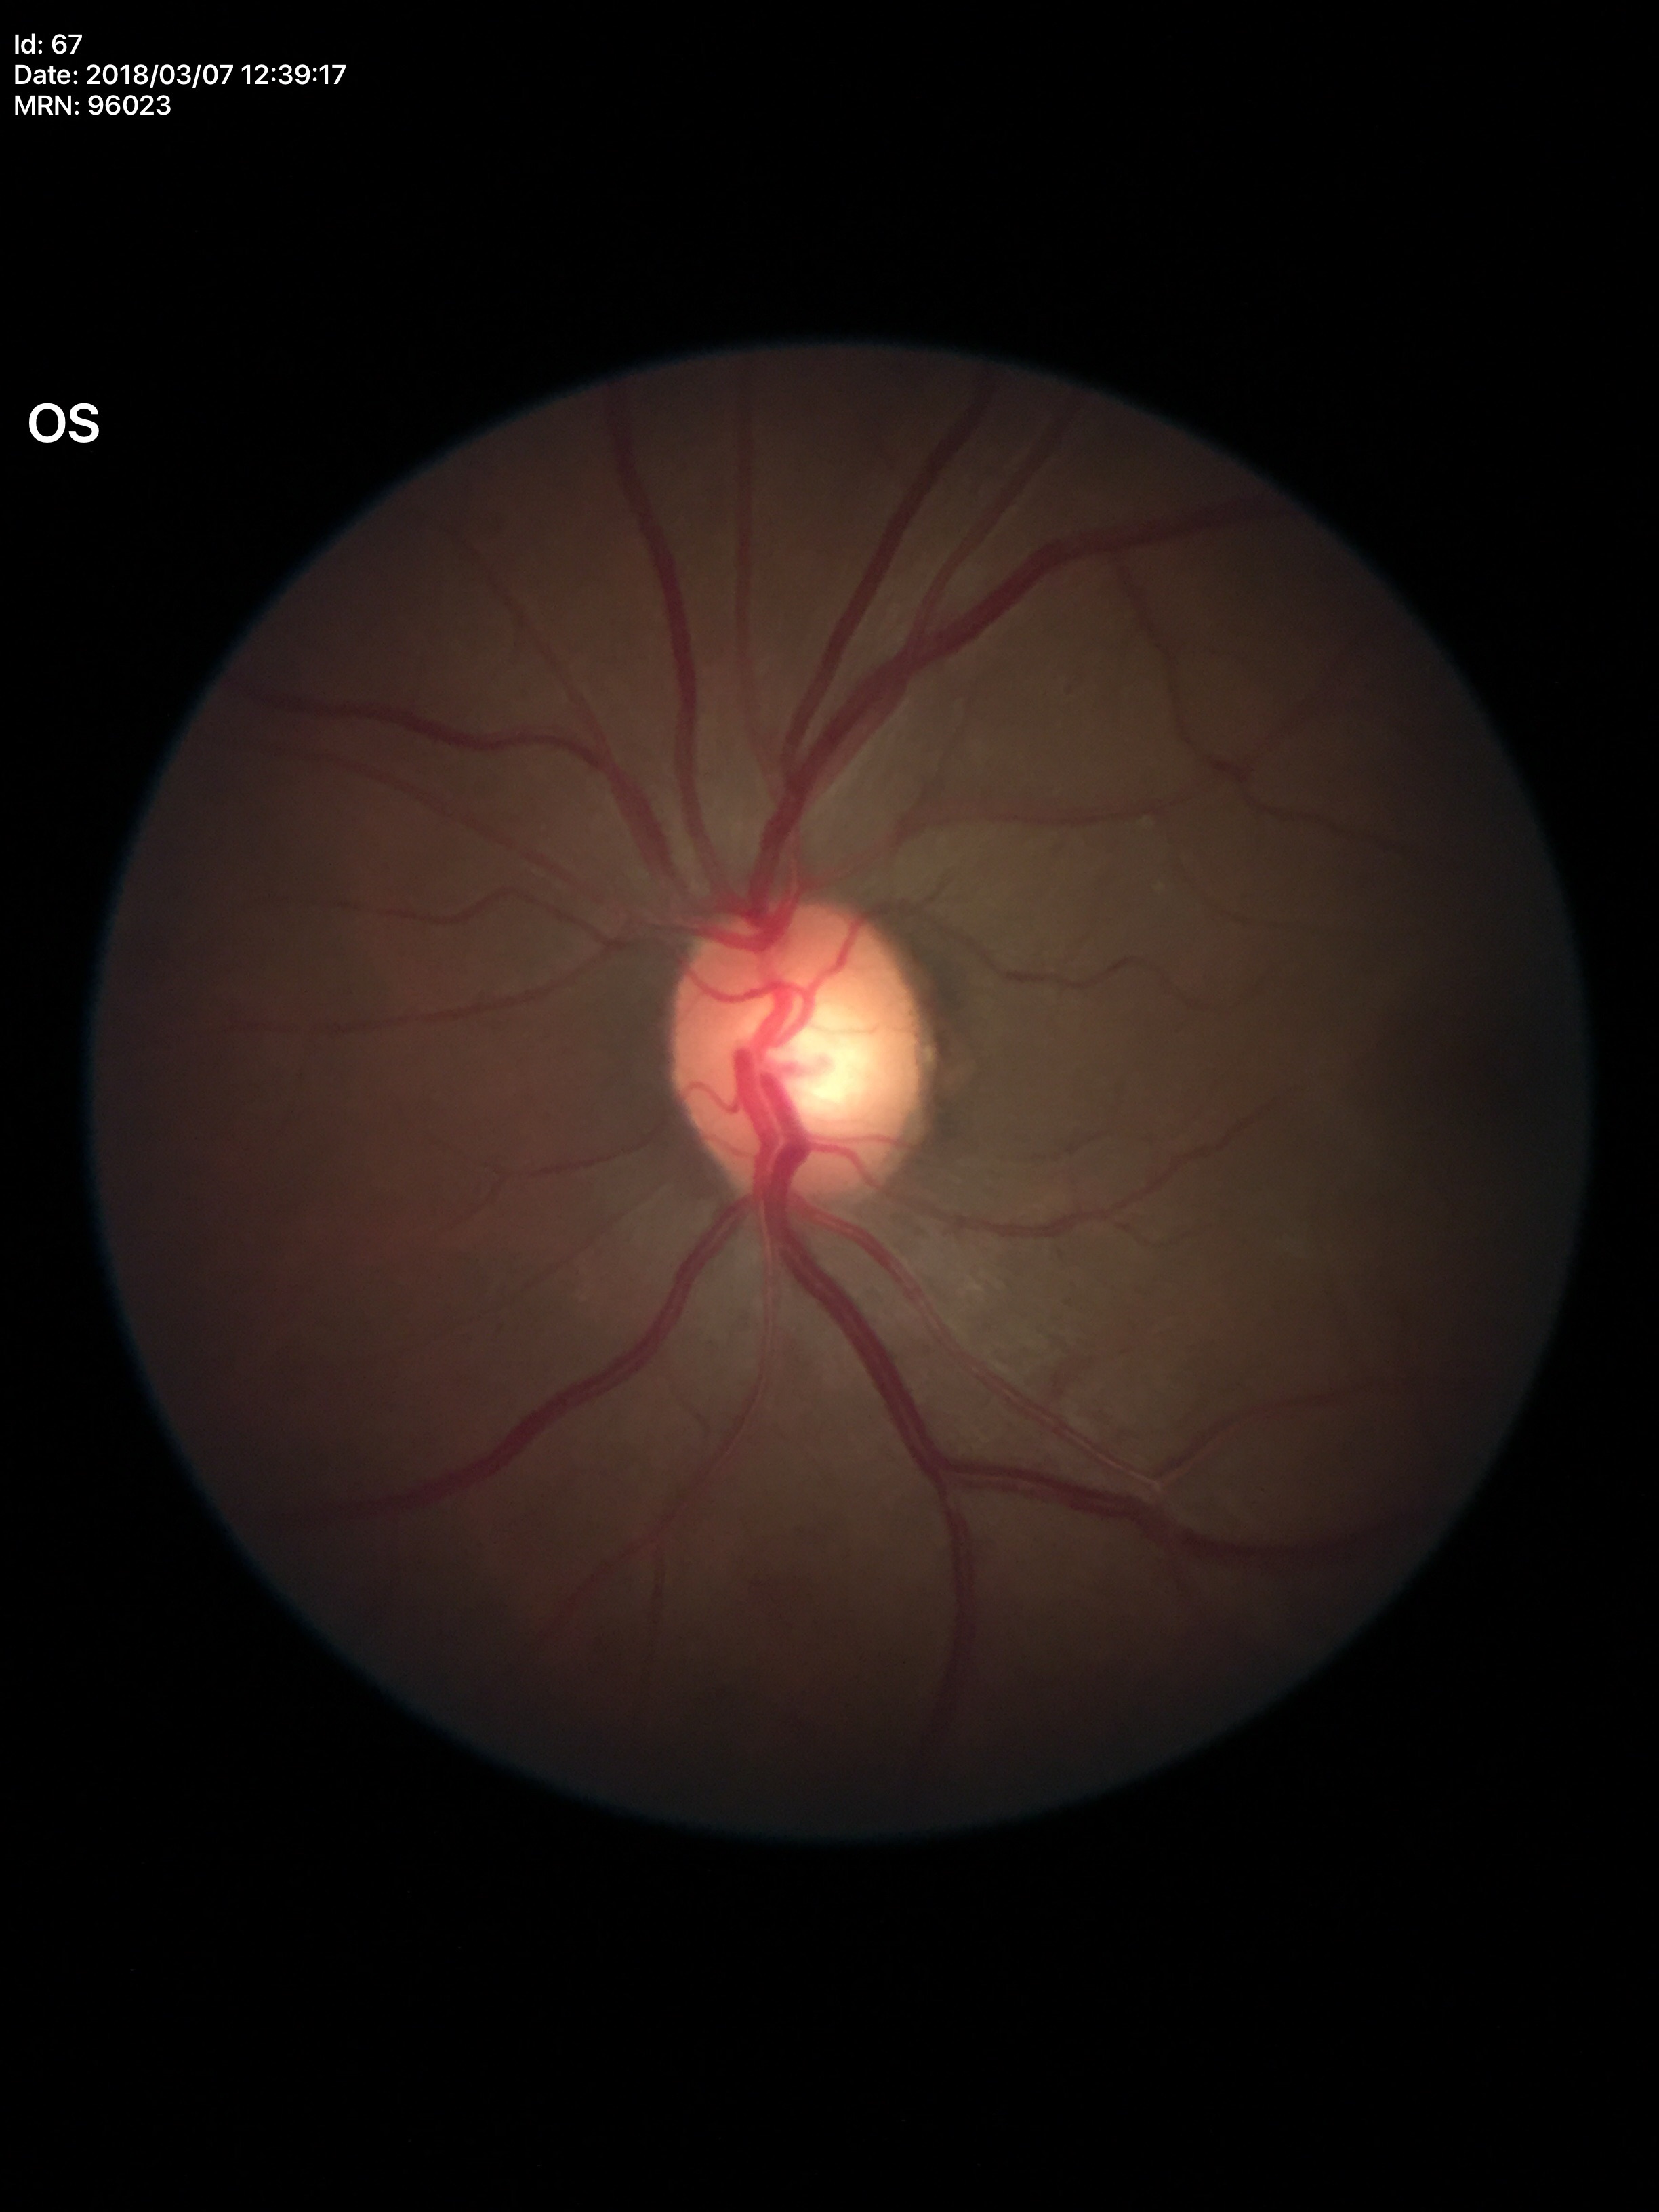
No evidence of glaucoma (2 of 5 graders flagged glaucoma suspect).
VCDR: 0.54.